Modified Davis classification, image size 848x848:
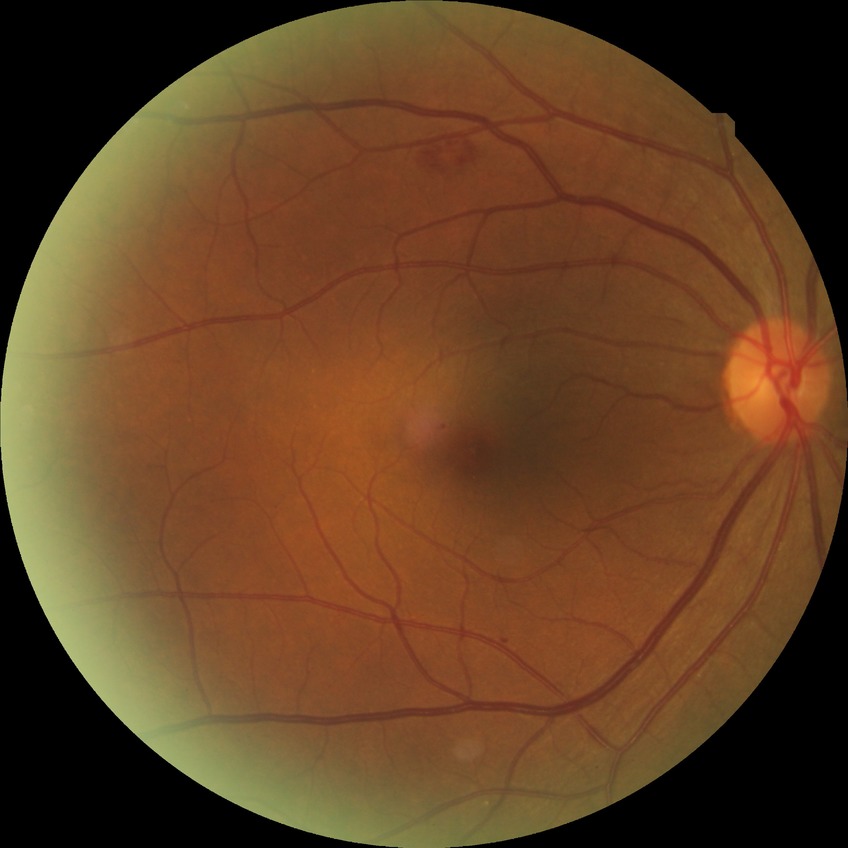

  proliferative_class: non-proliferative diabetic retinopathy
  davis_grade: simple diabetic retinopathy (SDR)